Wide-field fundus photograph from neonatal ROP screening: 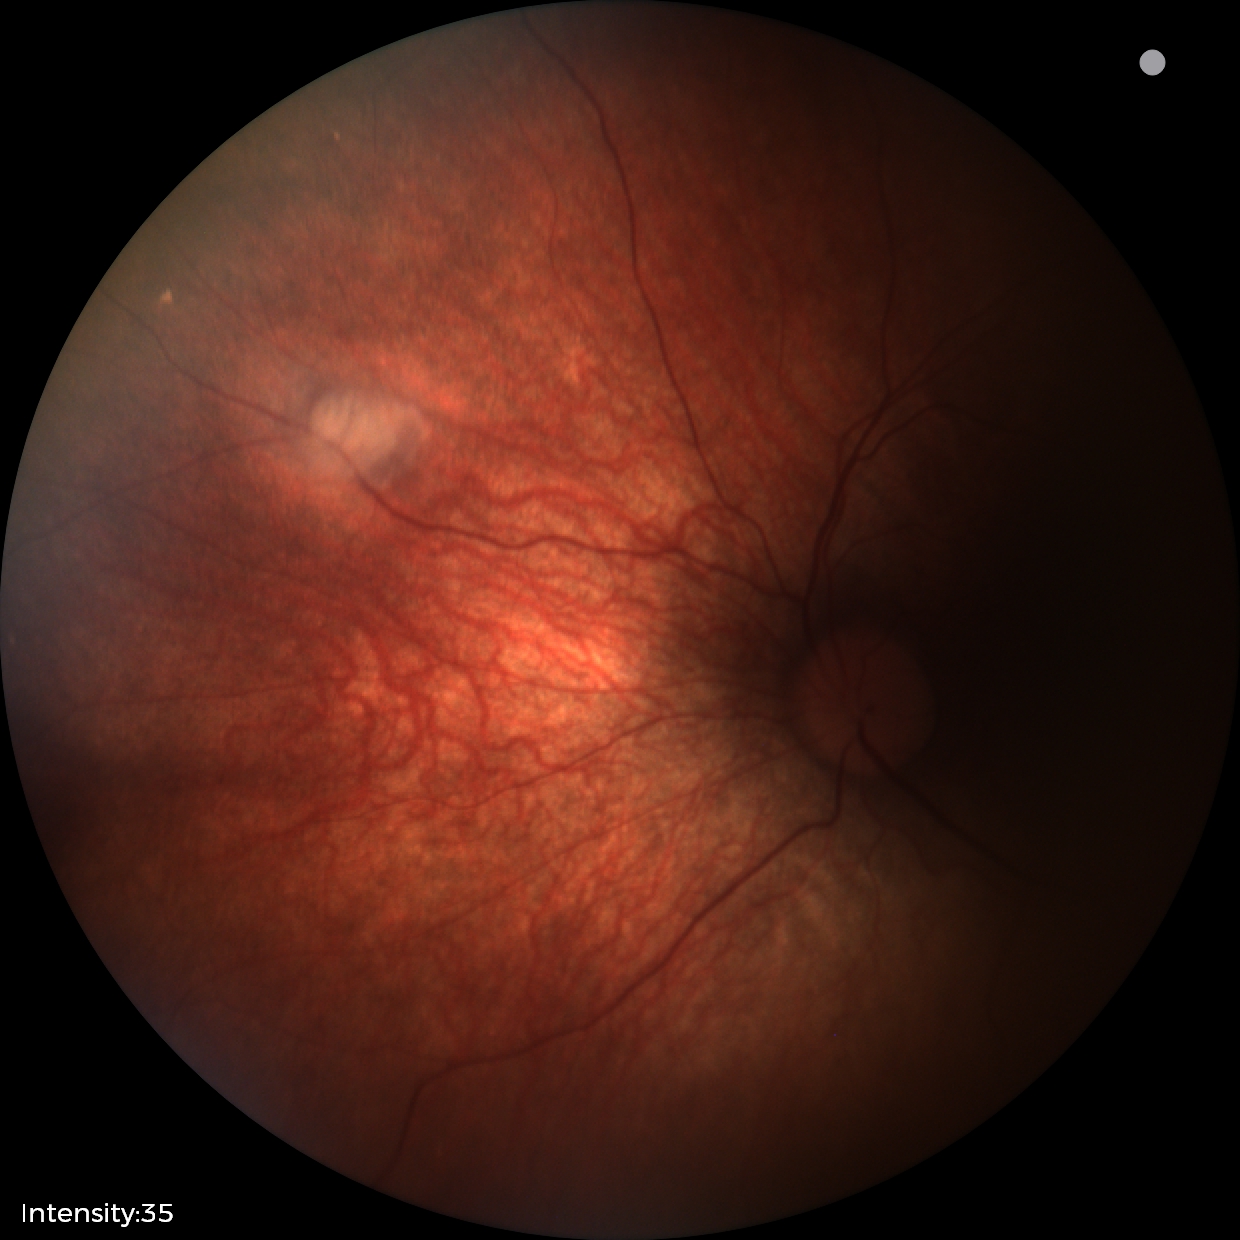

Examination diagnosed as retinal astrocytic hamartoma.